Fundus photo — 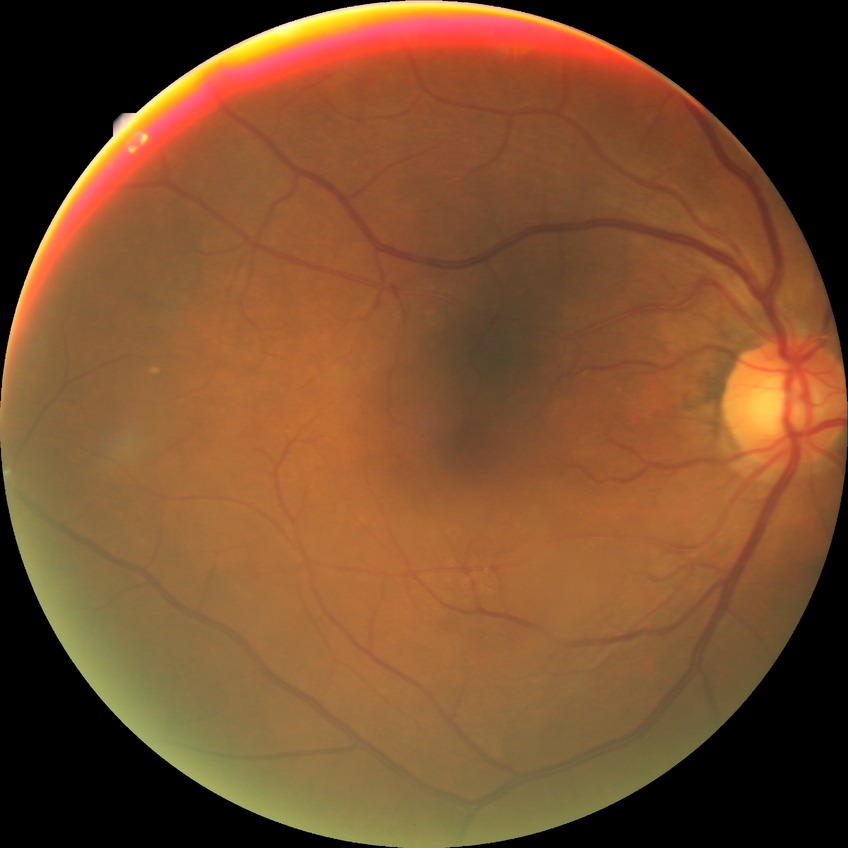 Diabetic retinopathy severity: no diabetic retinopathy.